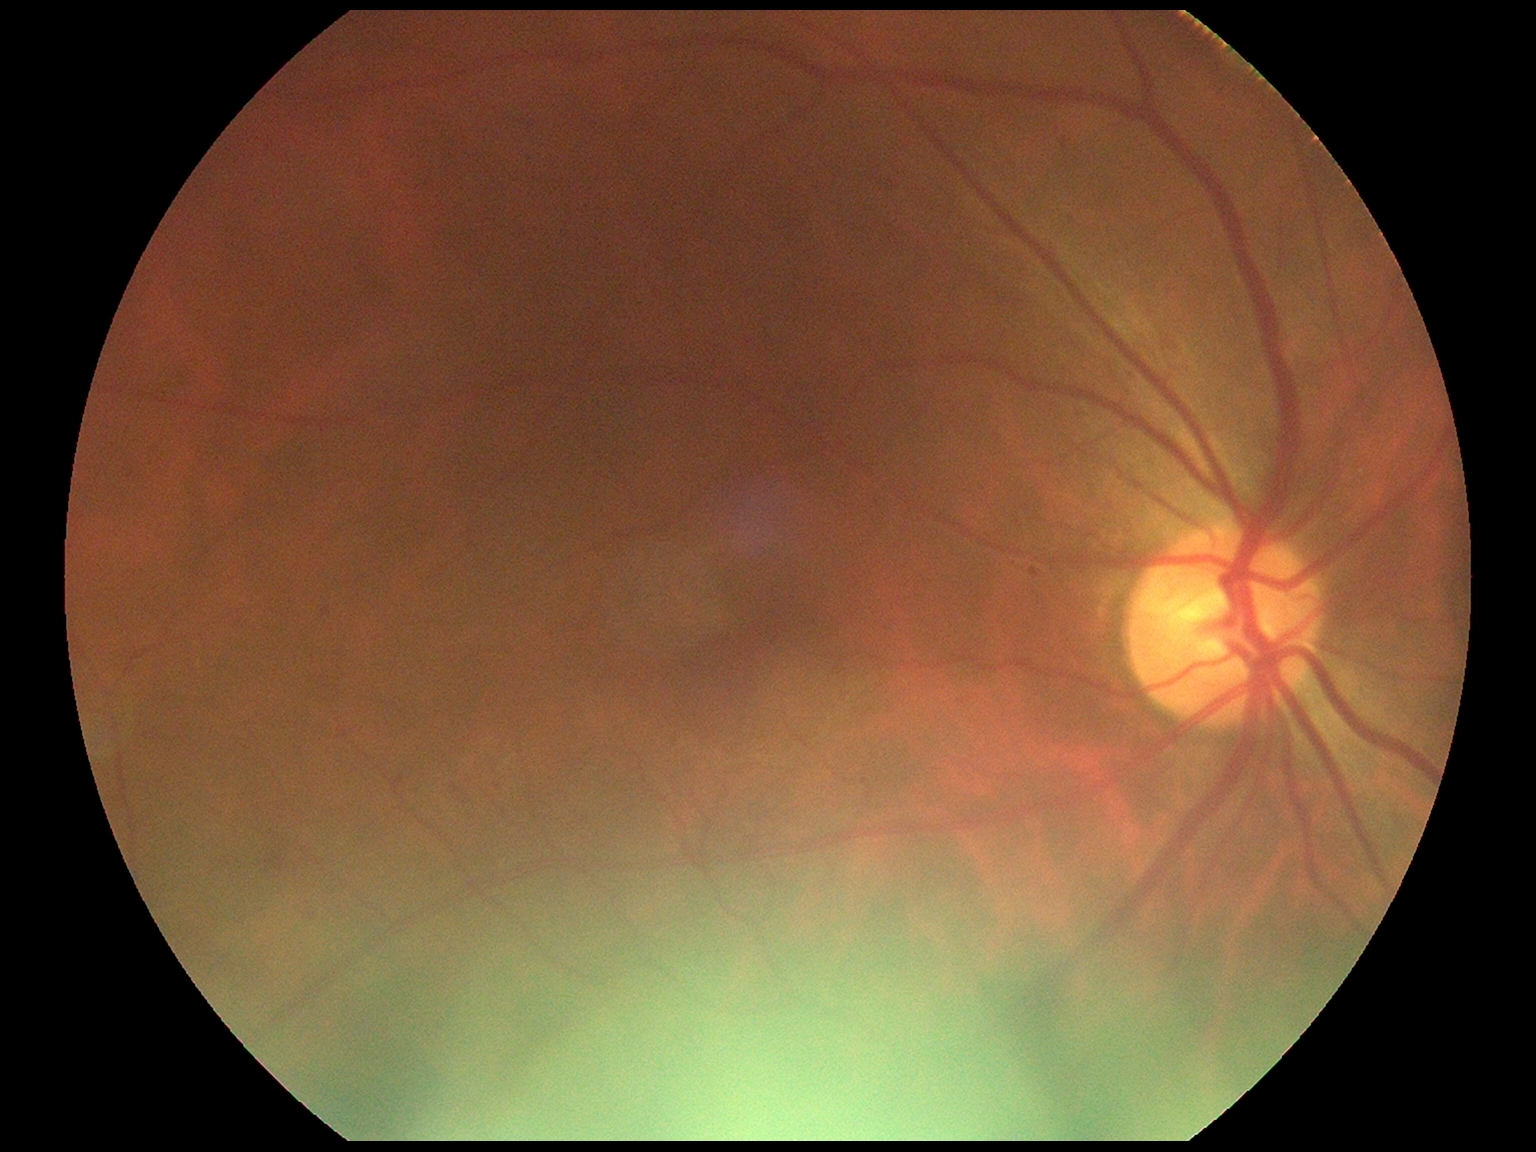

Findings:
- DR stage — grade 2